Modified Davis classification, no pharmacologic dilation — 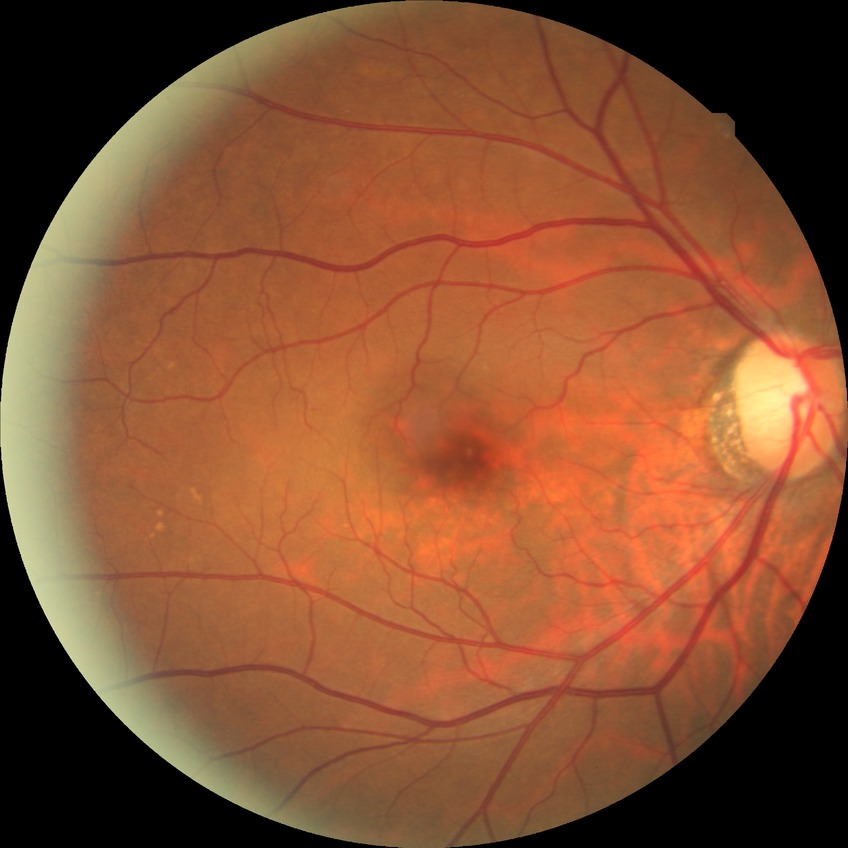
Diabetic retinopathy (DR): NDR (no diabetic retinopathy).